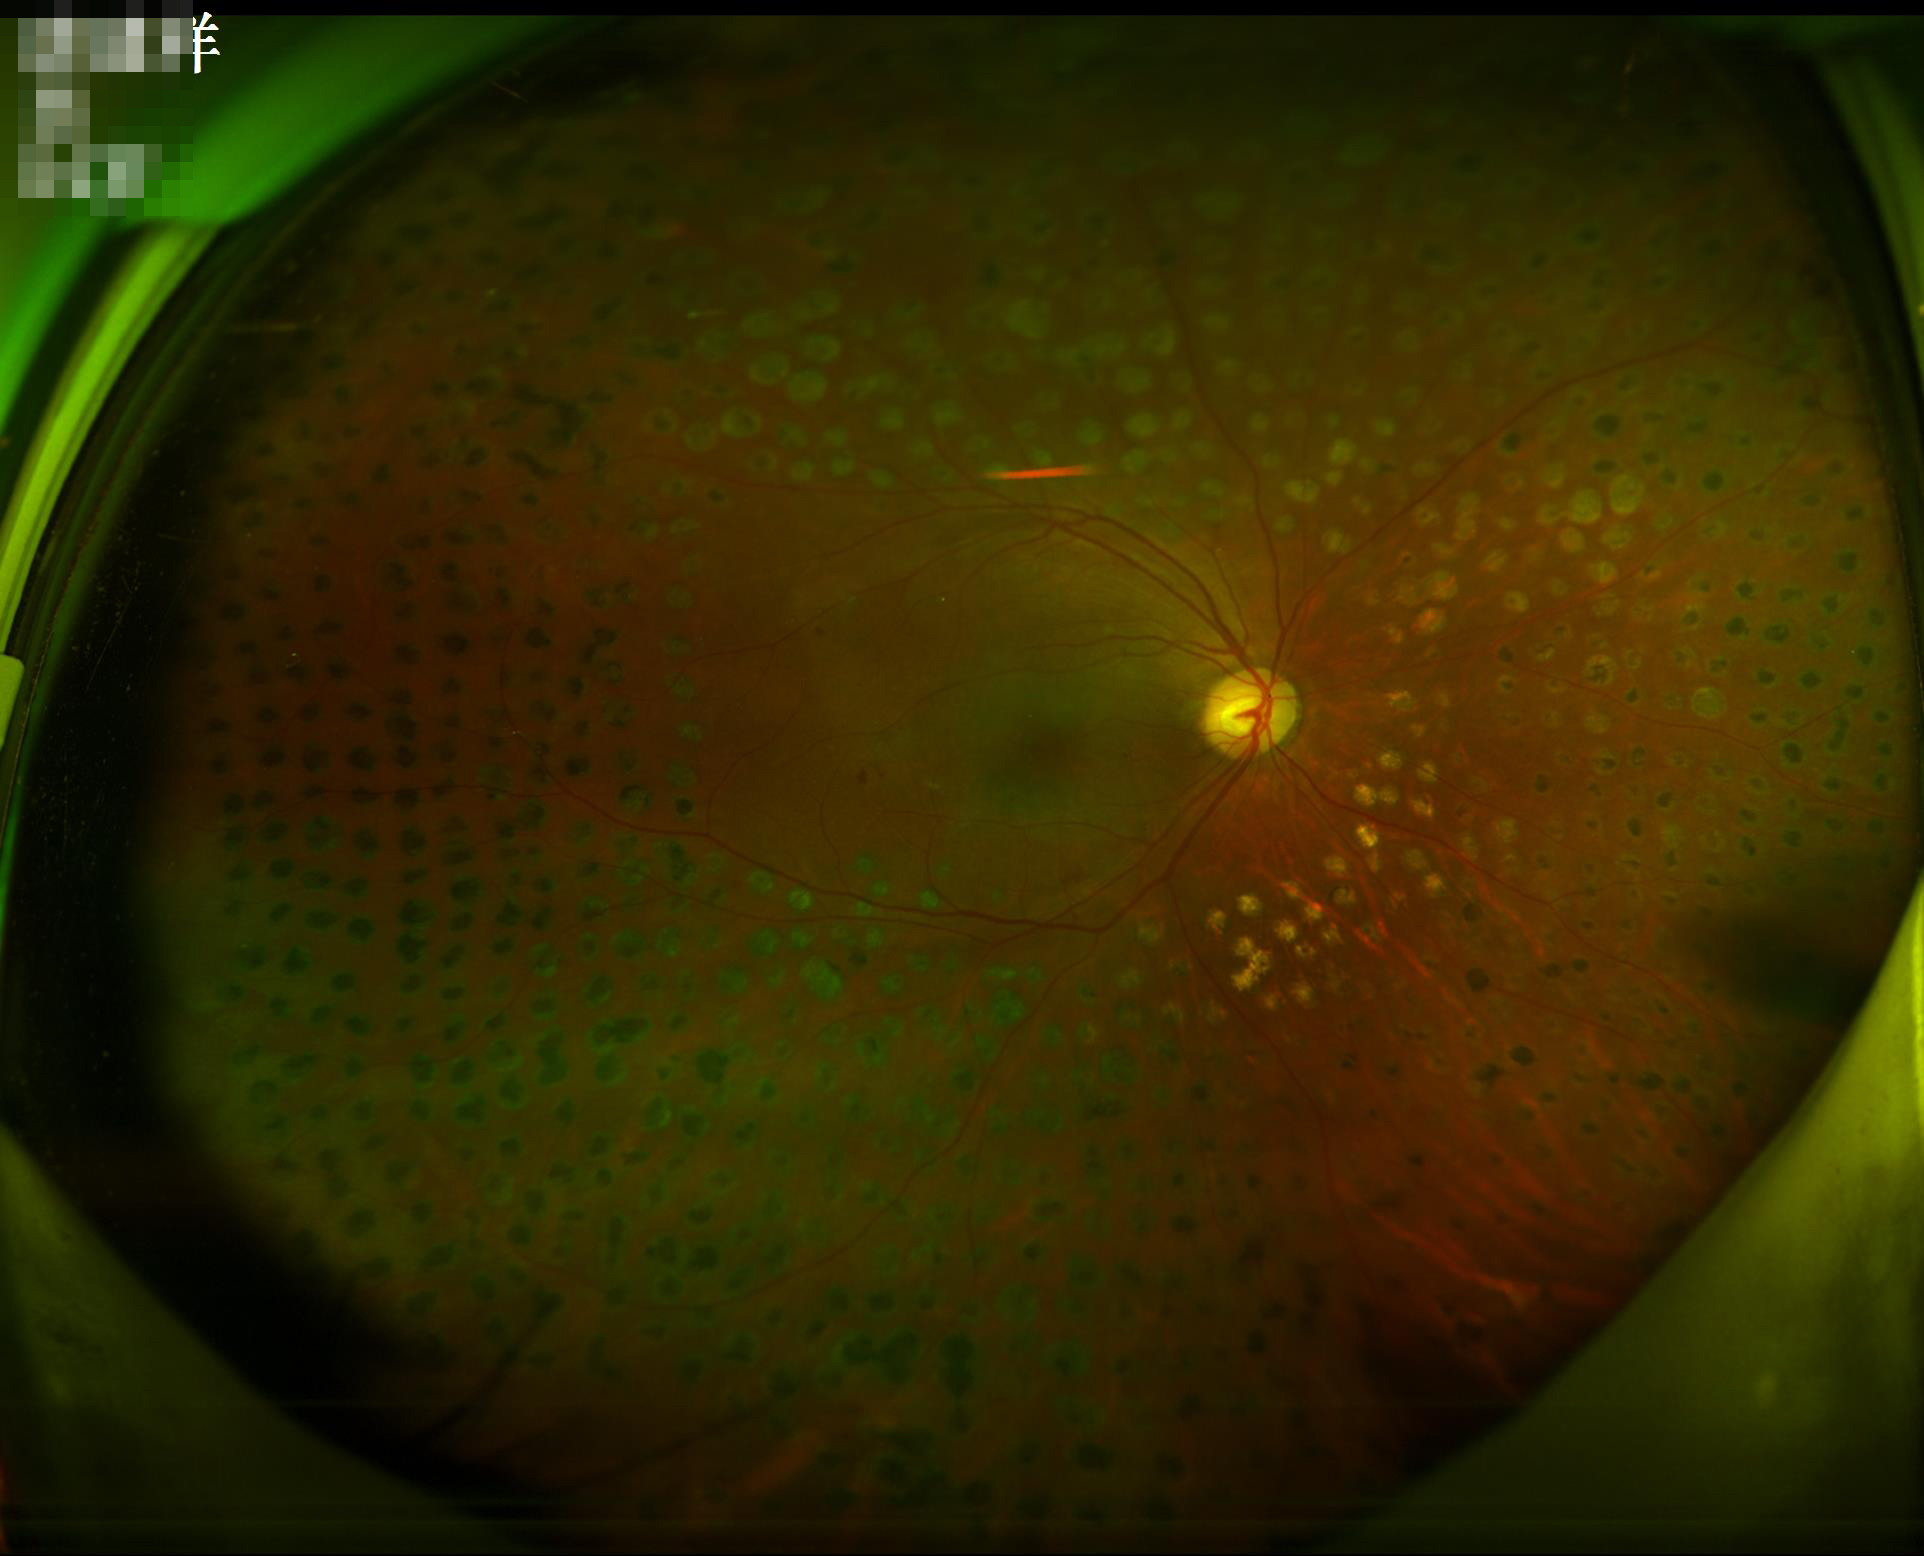

Image is sharp throughout the field.
Illumination and color are suboptimal.
Overall image quality is good.